45° FOV; 2212 x 1659 pixels; CFP:
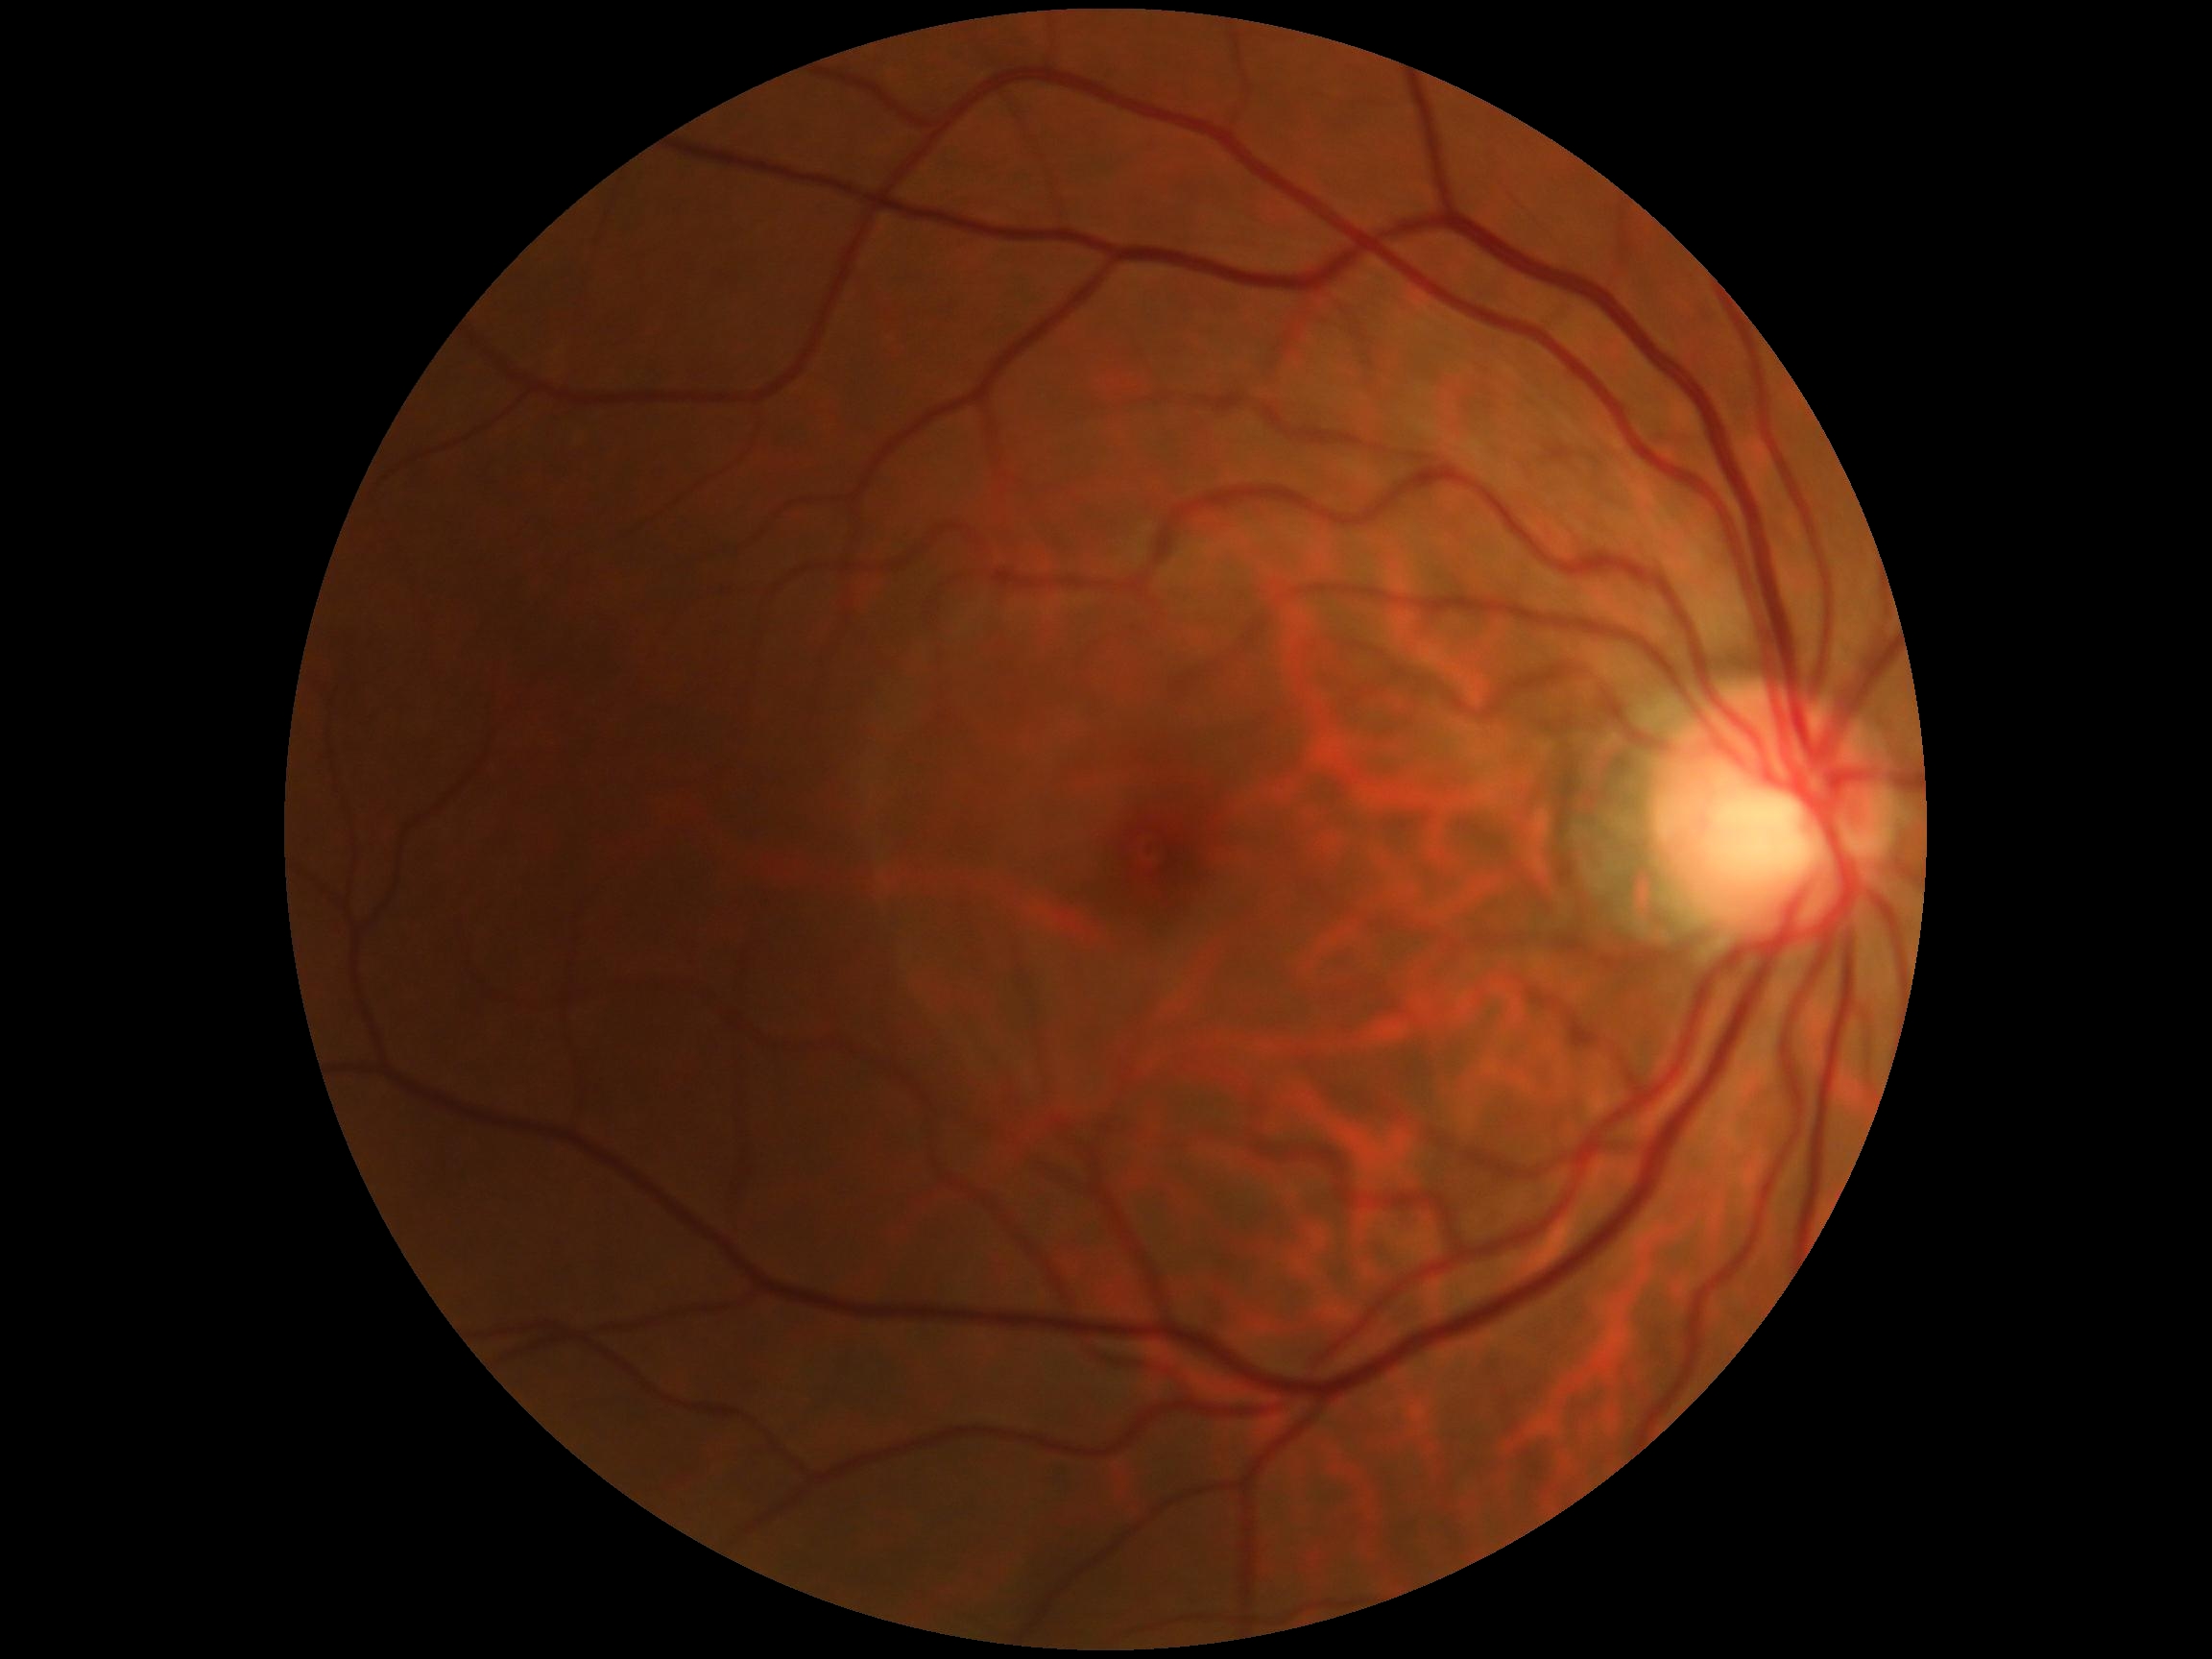 Diabetic retinopathy (DR) is grade 0.